640x480px. Wide-field contact fundus photograph of an infant:
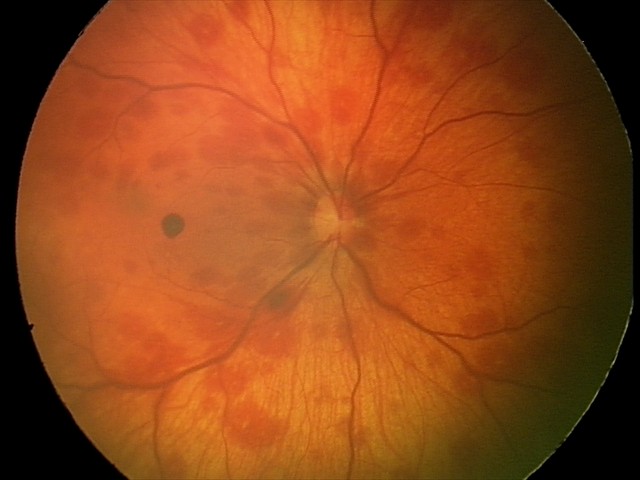

Series diagnosed as retinal hemorrhages.